45-degree field of view.
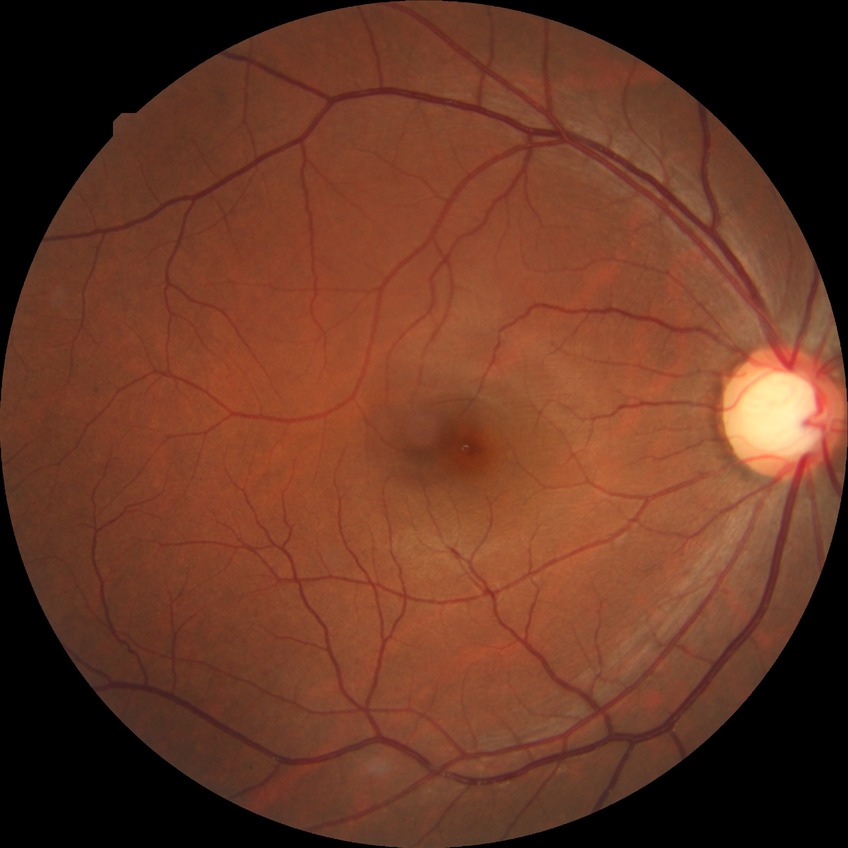

Findings:
- modified Davis grading: no diabetic retinopathy